Camera: Nidek AFC-330 · disc-centered field: 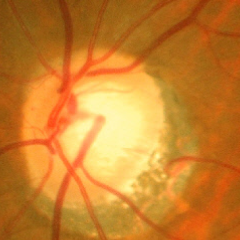
Impression: early-stage glaucoma. Diagnostic criteria: glaucomatous retinal nerve fiber layer defects on red-free fundus photography without visual field defects.